Image size 2048x1536. Captured on a Forus 3Nethra fundus camera:
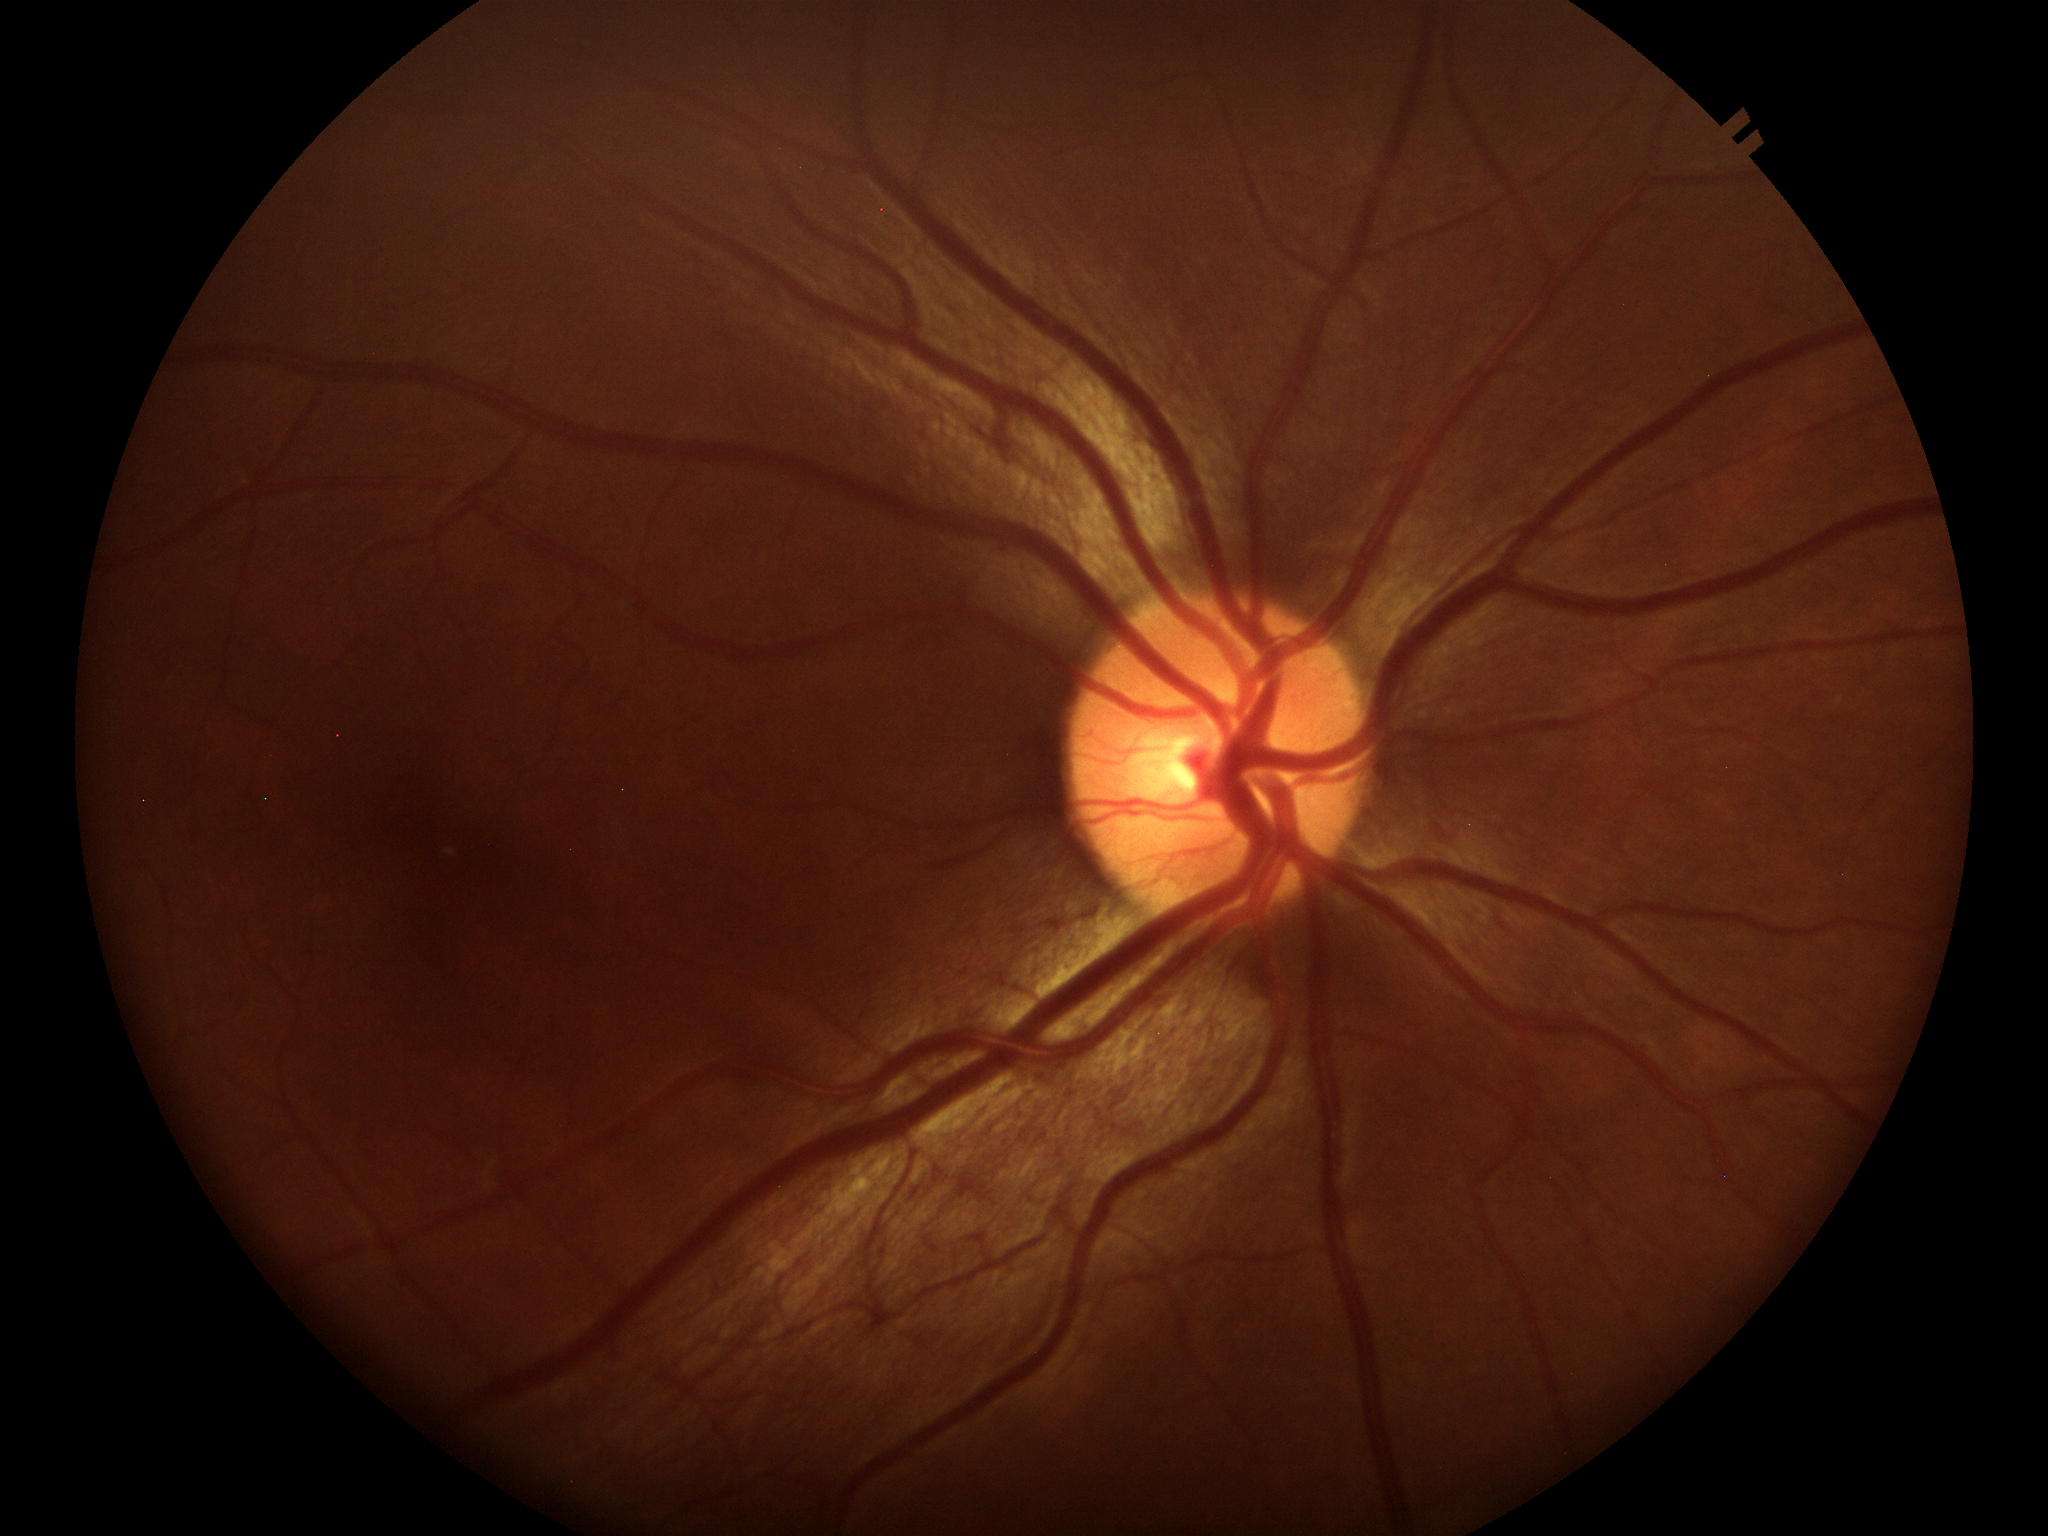

No evidence of glaucoma.
Vertical CDR of 0.42.
Horizontal CDR of 0.45.